2352x1568 · retinal fundus photograph: 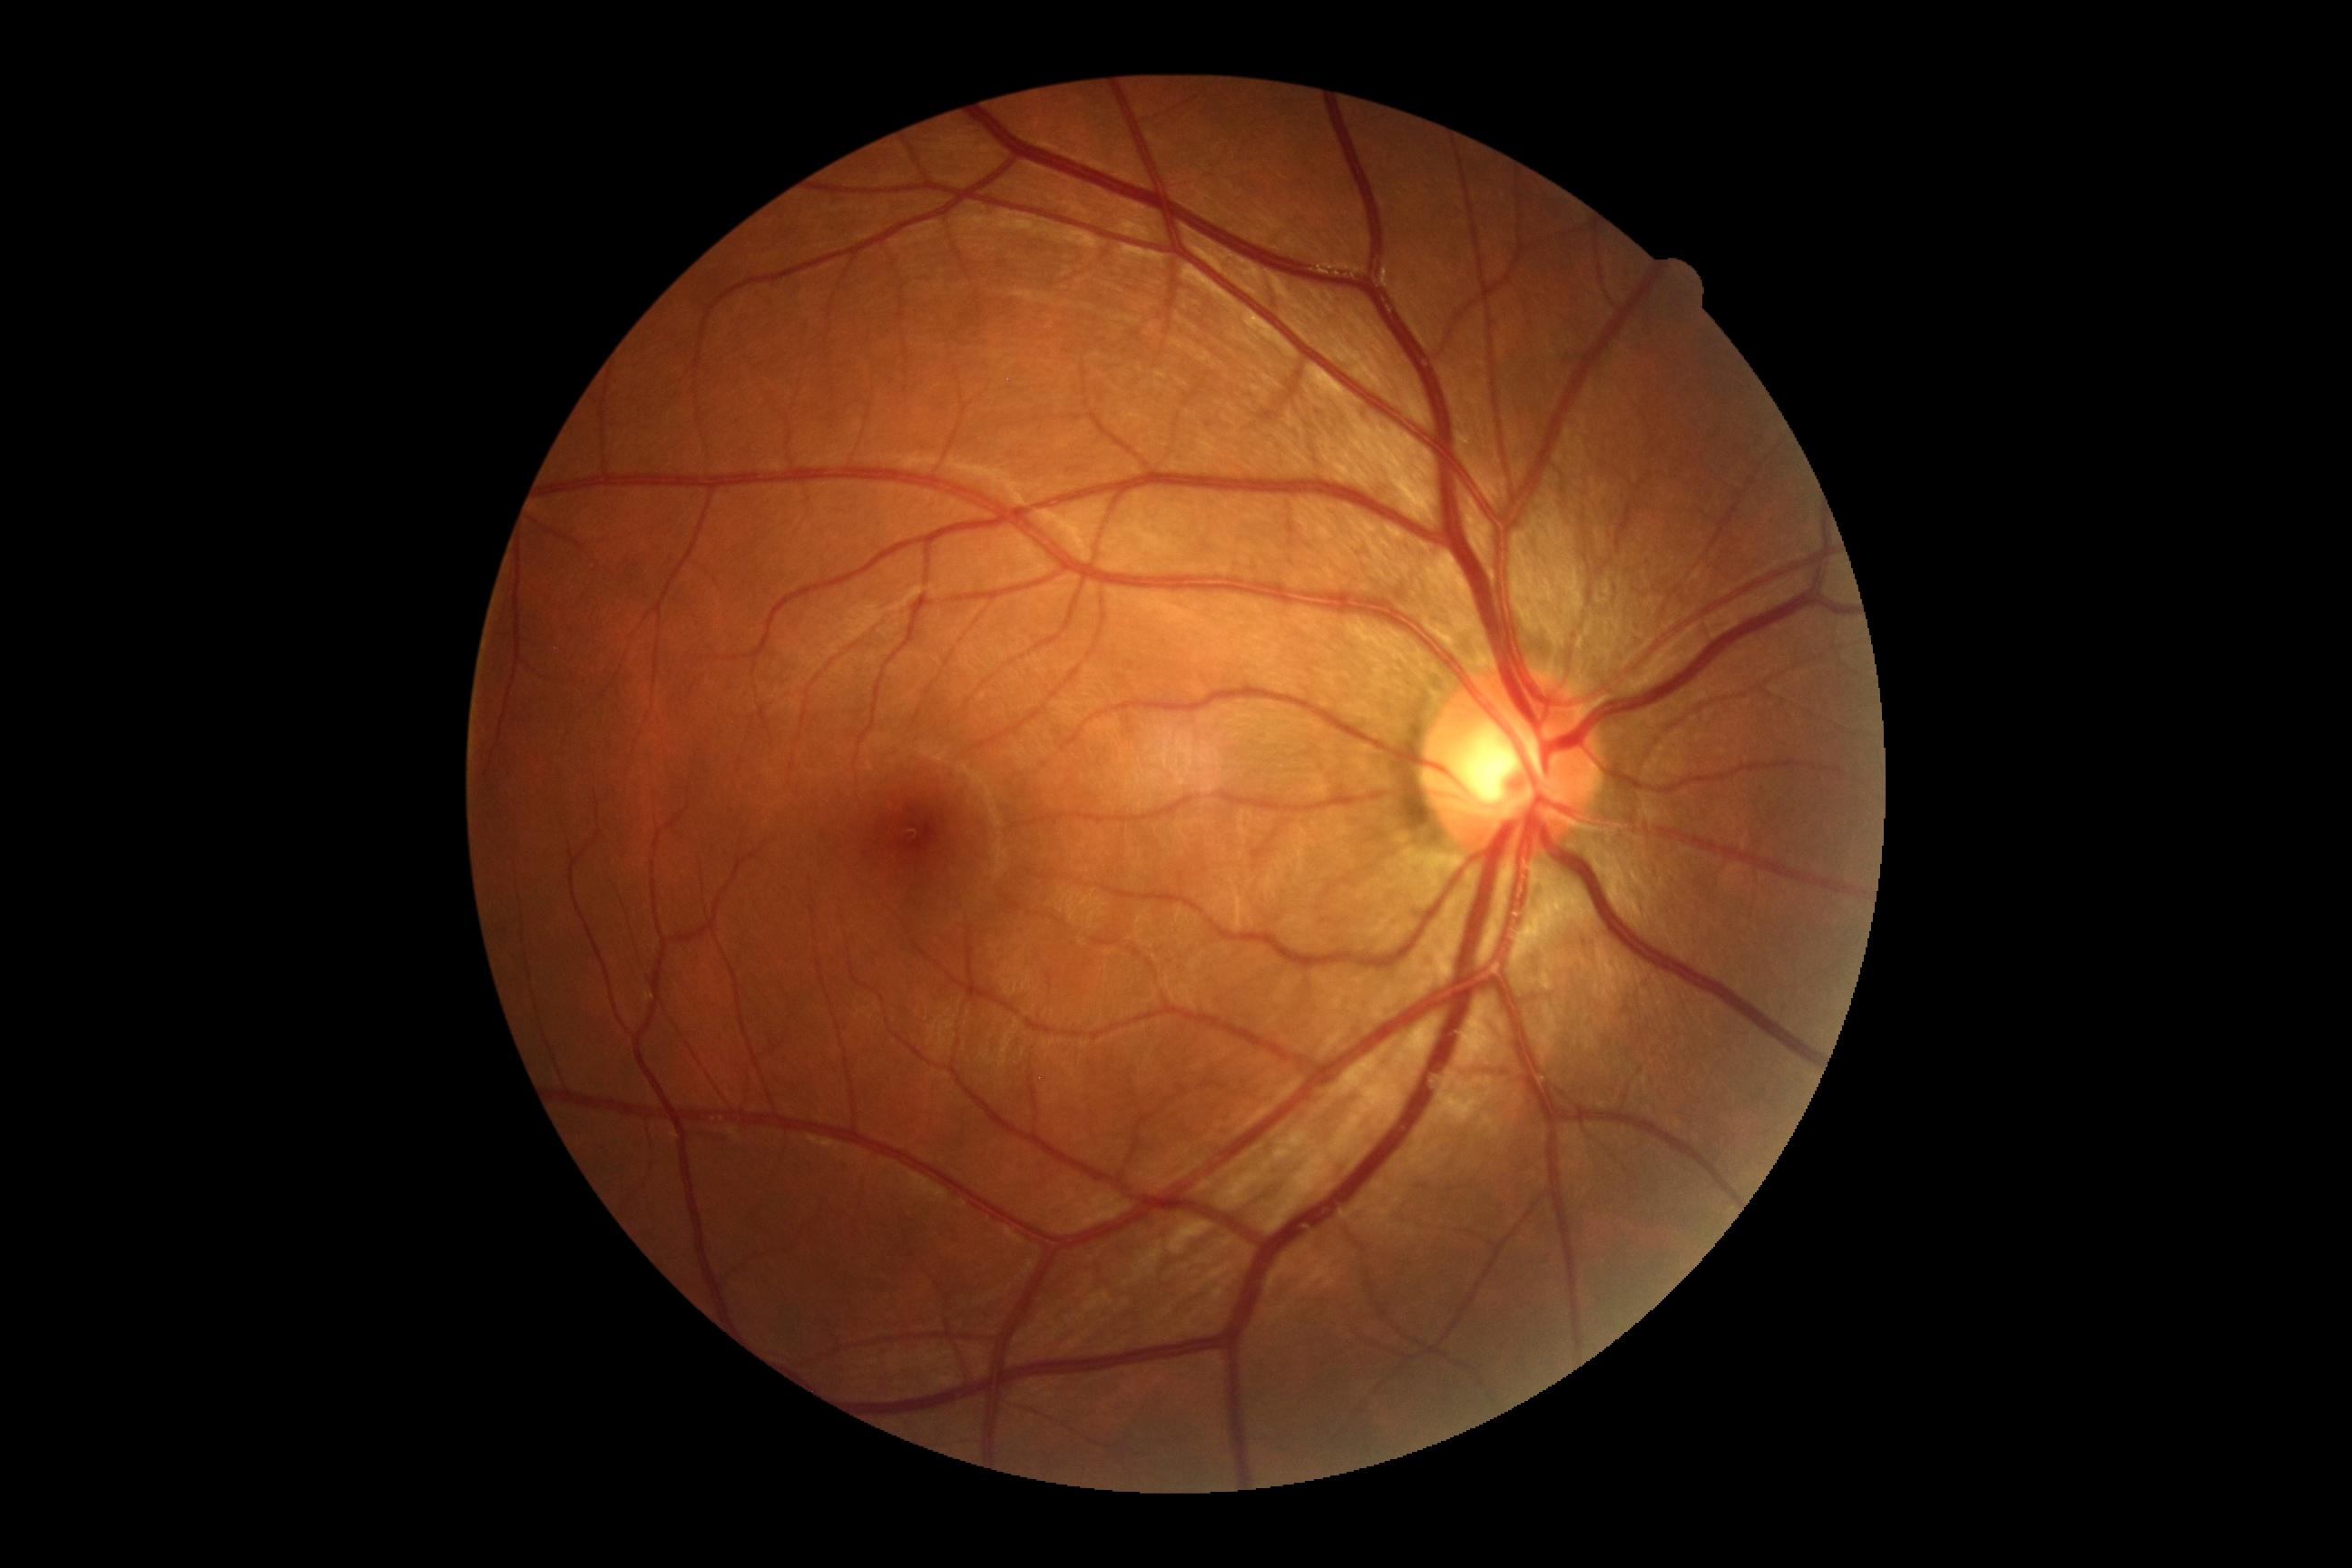
* DR impression — no signs of DR
* DR severity — no apparent diabetic retinopathy (grade 0)